Wide-field contact fundus photograph of an infant. Camera: Phoenix ICON (100° FOV):
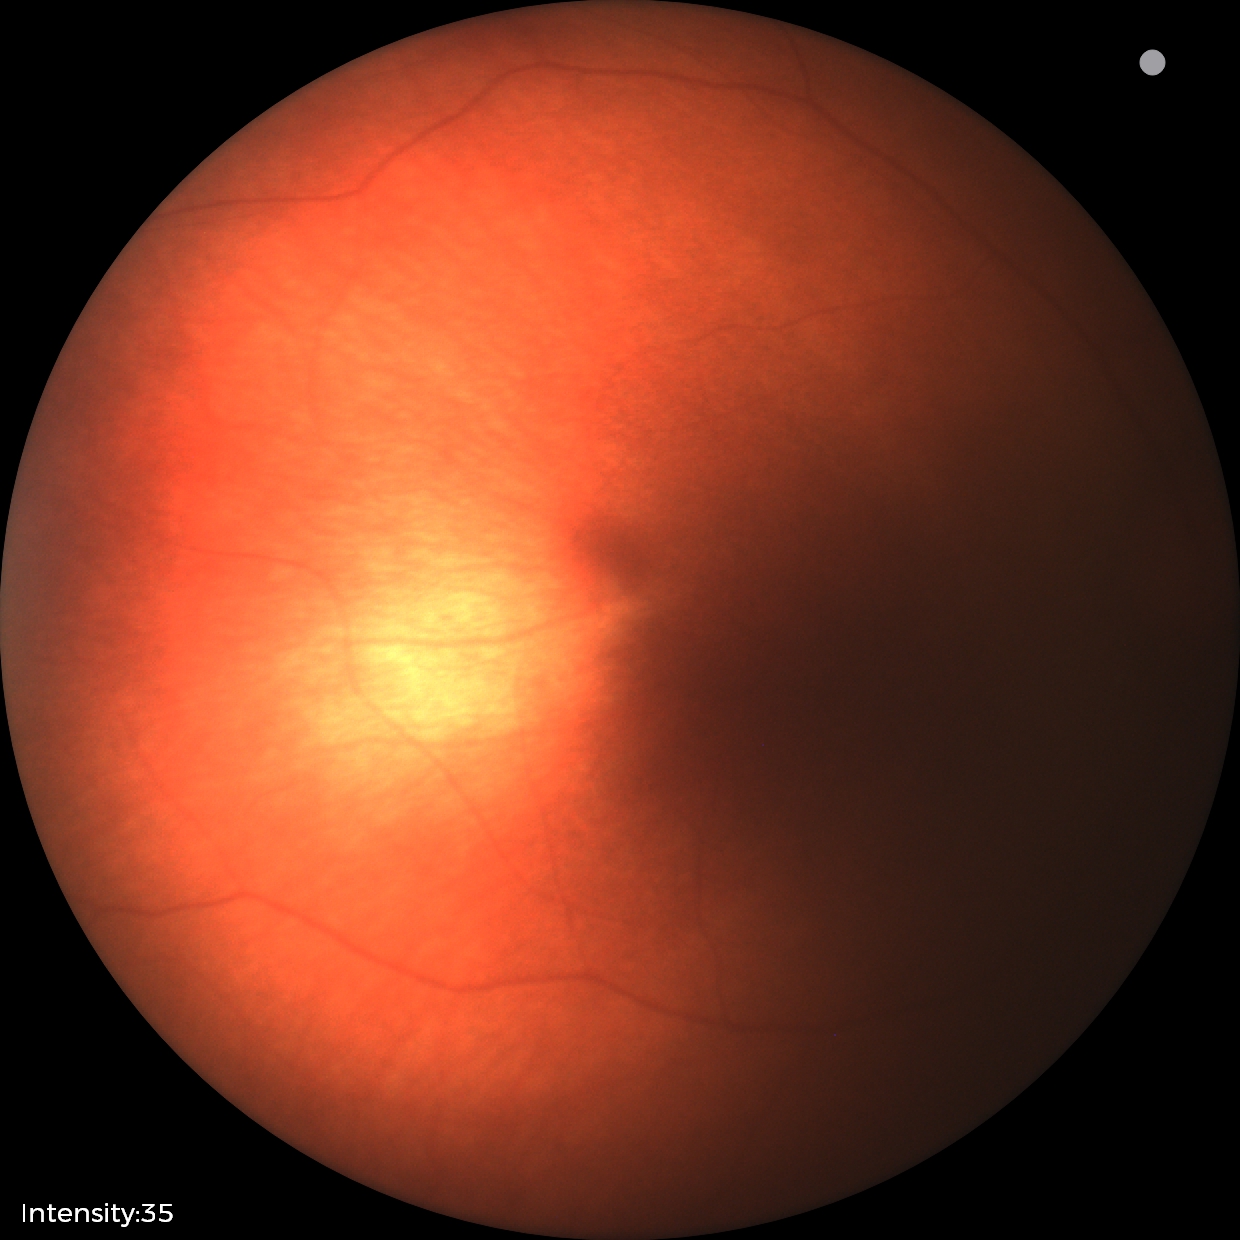 Screening diagnosis = physiological.